Without pupil dilation
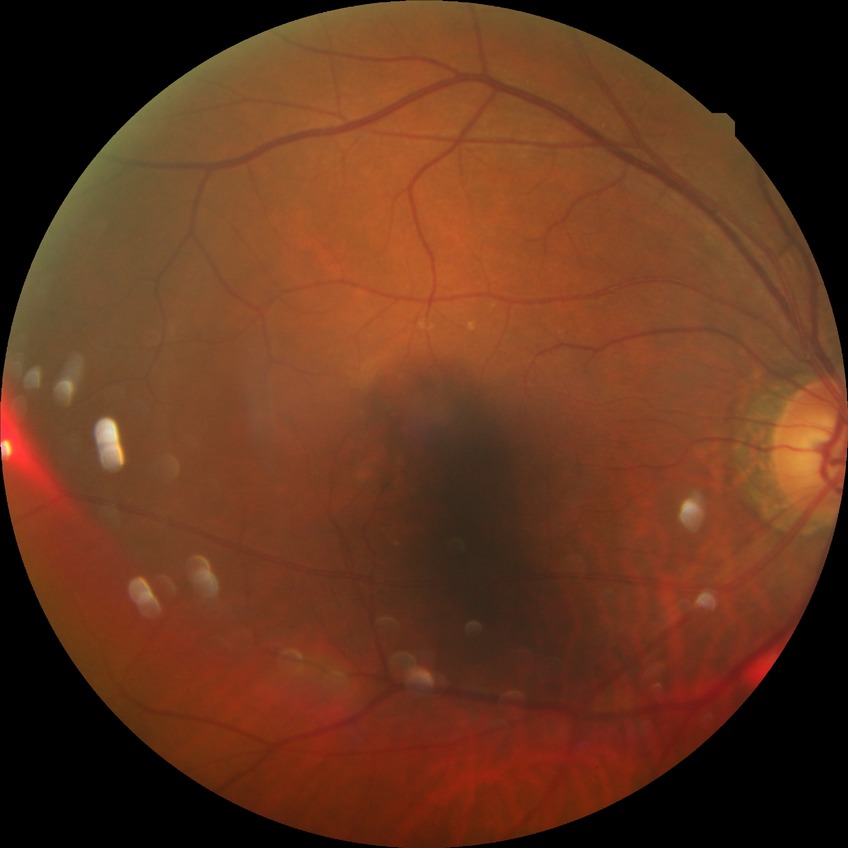

diabetic retinopathy (DR)=no diabetic retinopathy (NDR).